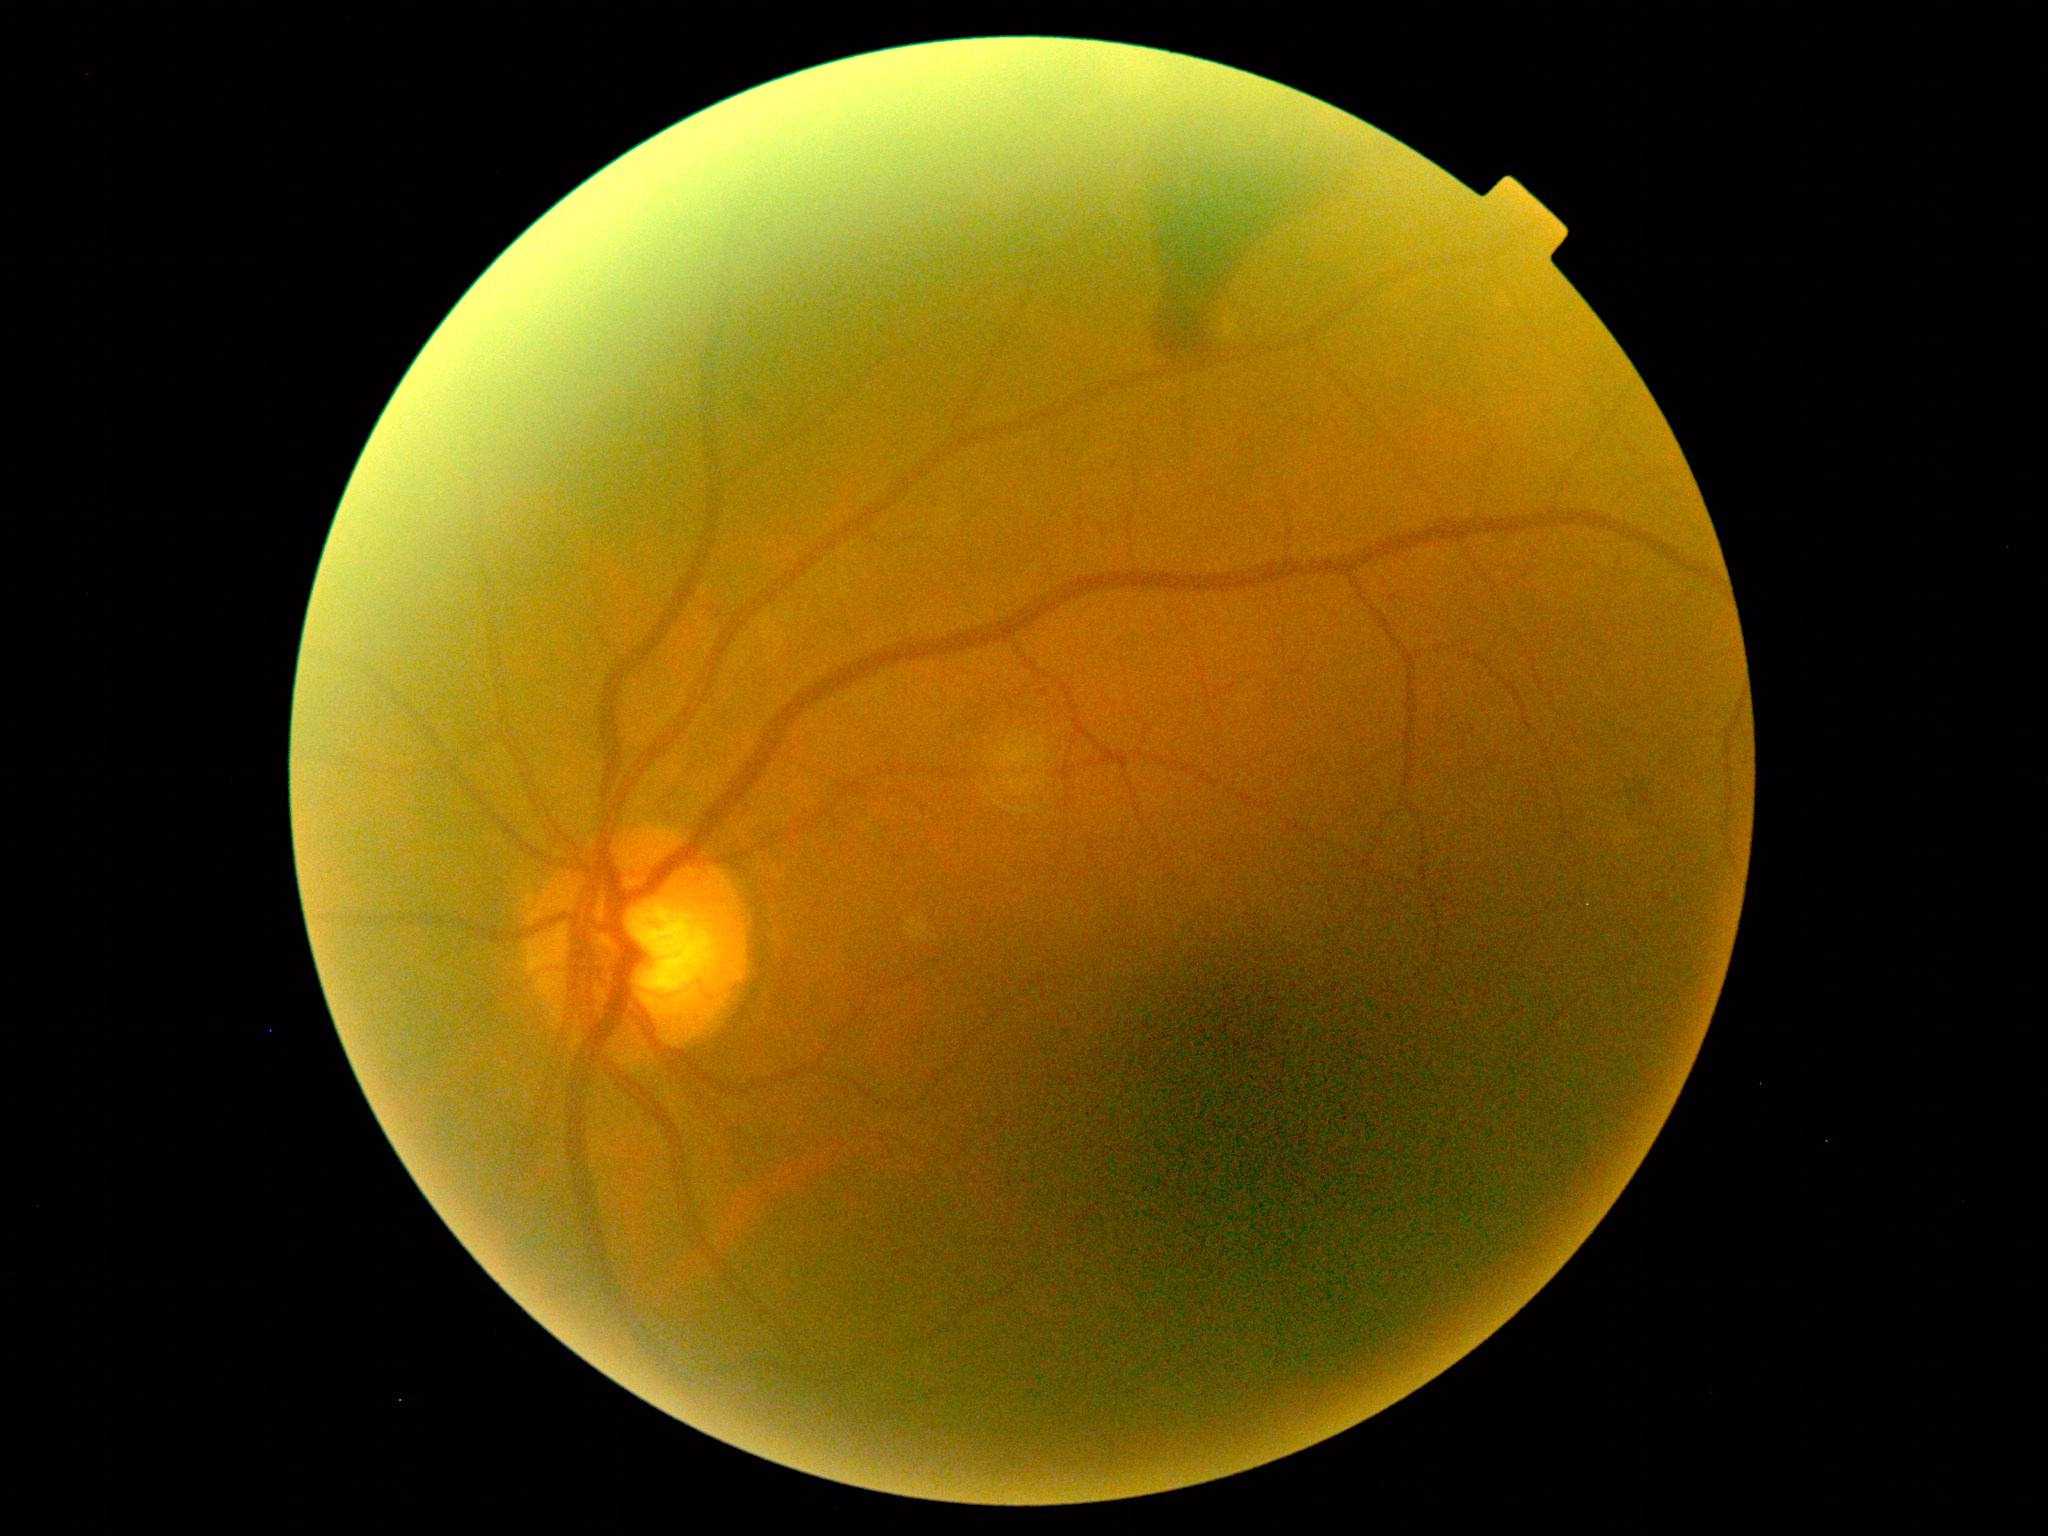 Disease class: proliferative diabetic retinopathy.
Diabetic retinopathy grade is PDR (4).